Graded on the modified Davis scale; nonmydriatic; 45 degree fundus photograph; acquired with a NIDEK AFC-230; 848 by 848 pixels — 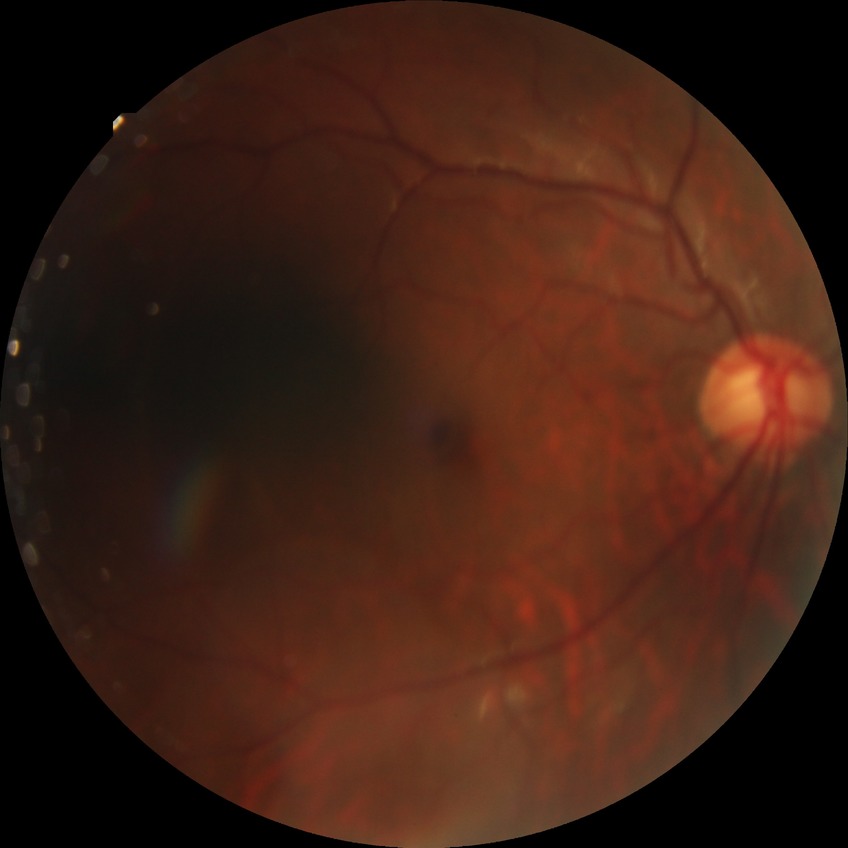
Annotations:
- diabetic retinopathy grade — no diabetic retinopathy